Pediatric retinal photograph (wide-field)
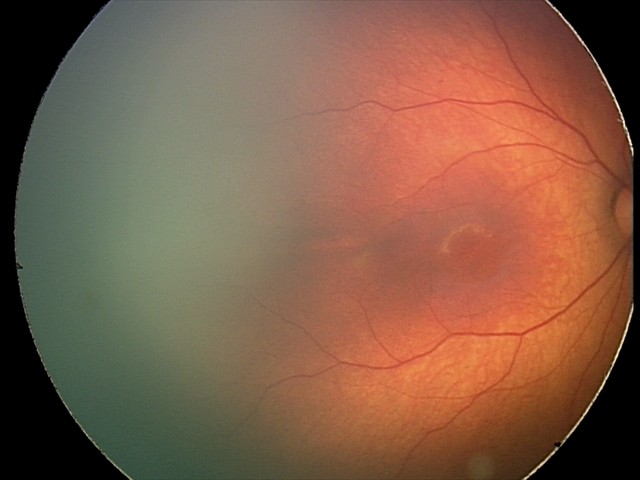

Screening examination with no abnormal retinal findings.